Acquired with a NIDEK AFC-230:
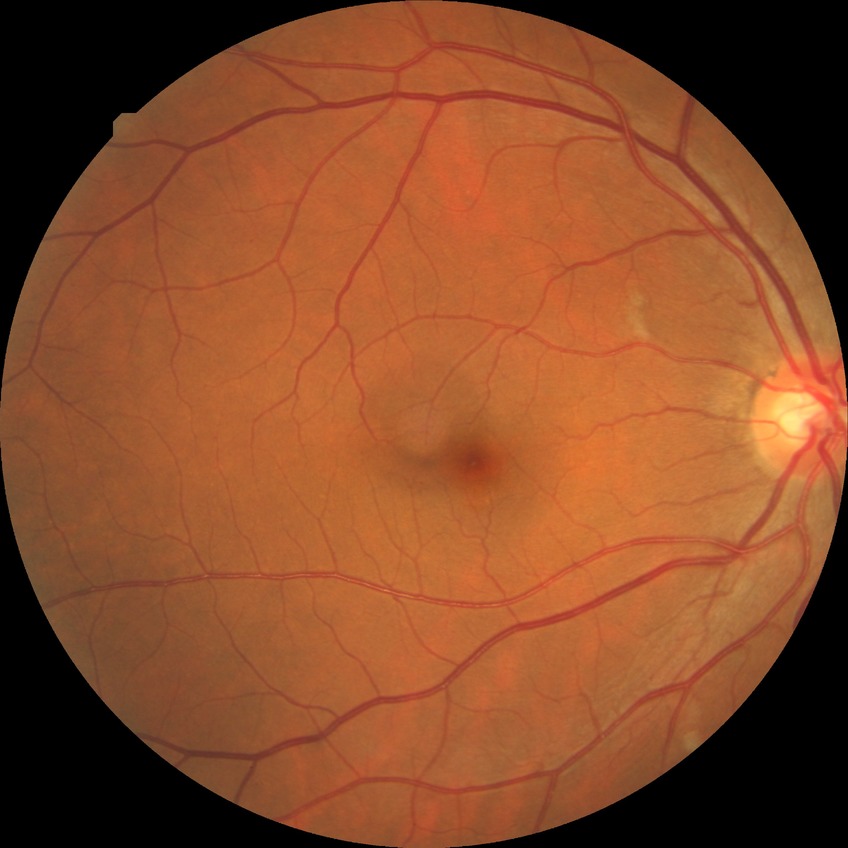 Annotations:
– diabetic retinopathy severity — simple diabetic retinopathy
– DR class — non-proliferative diabetic retinopathy